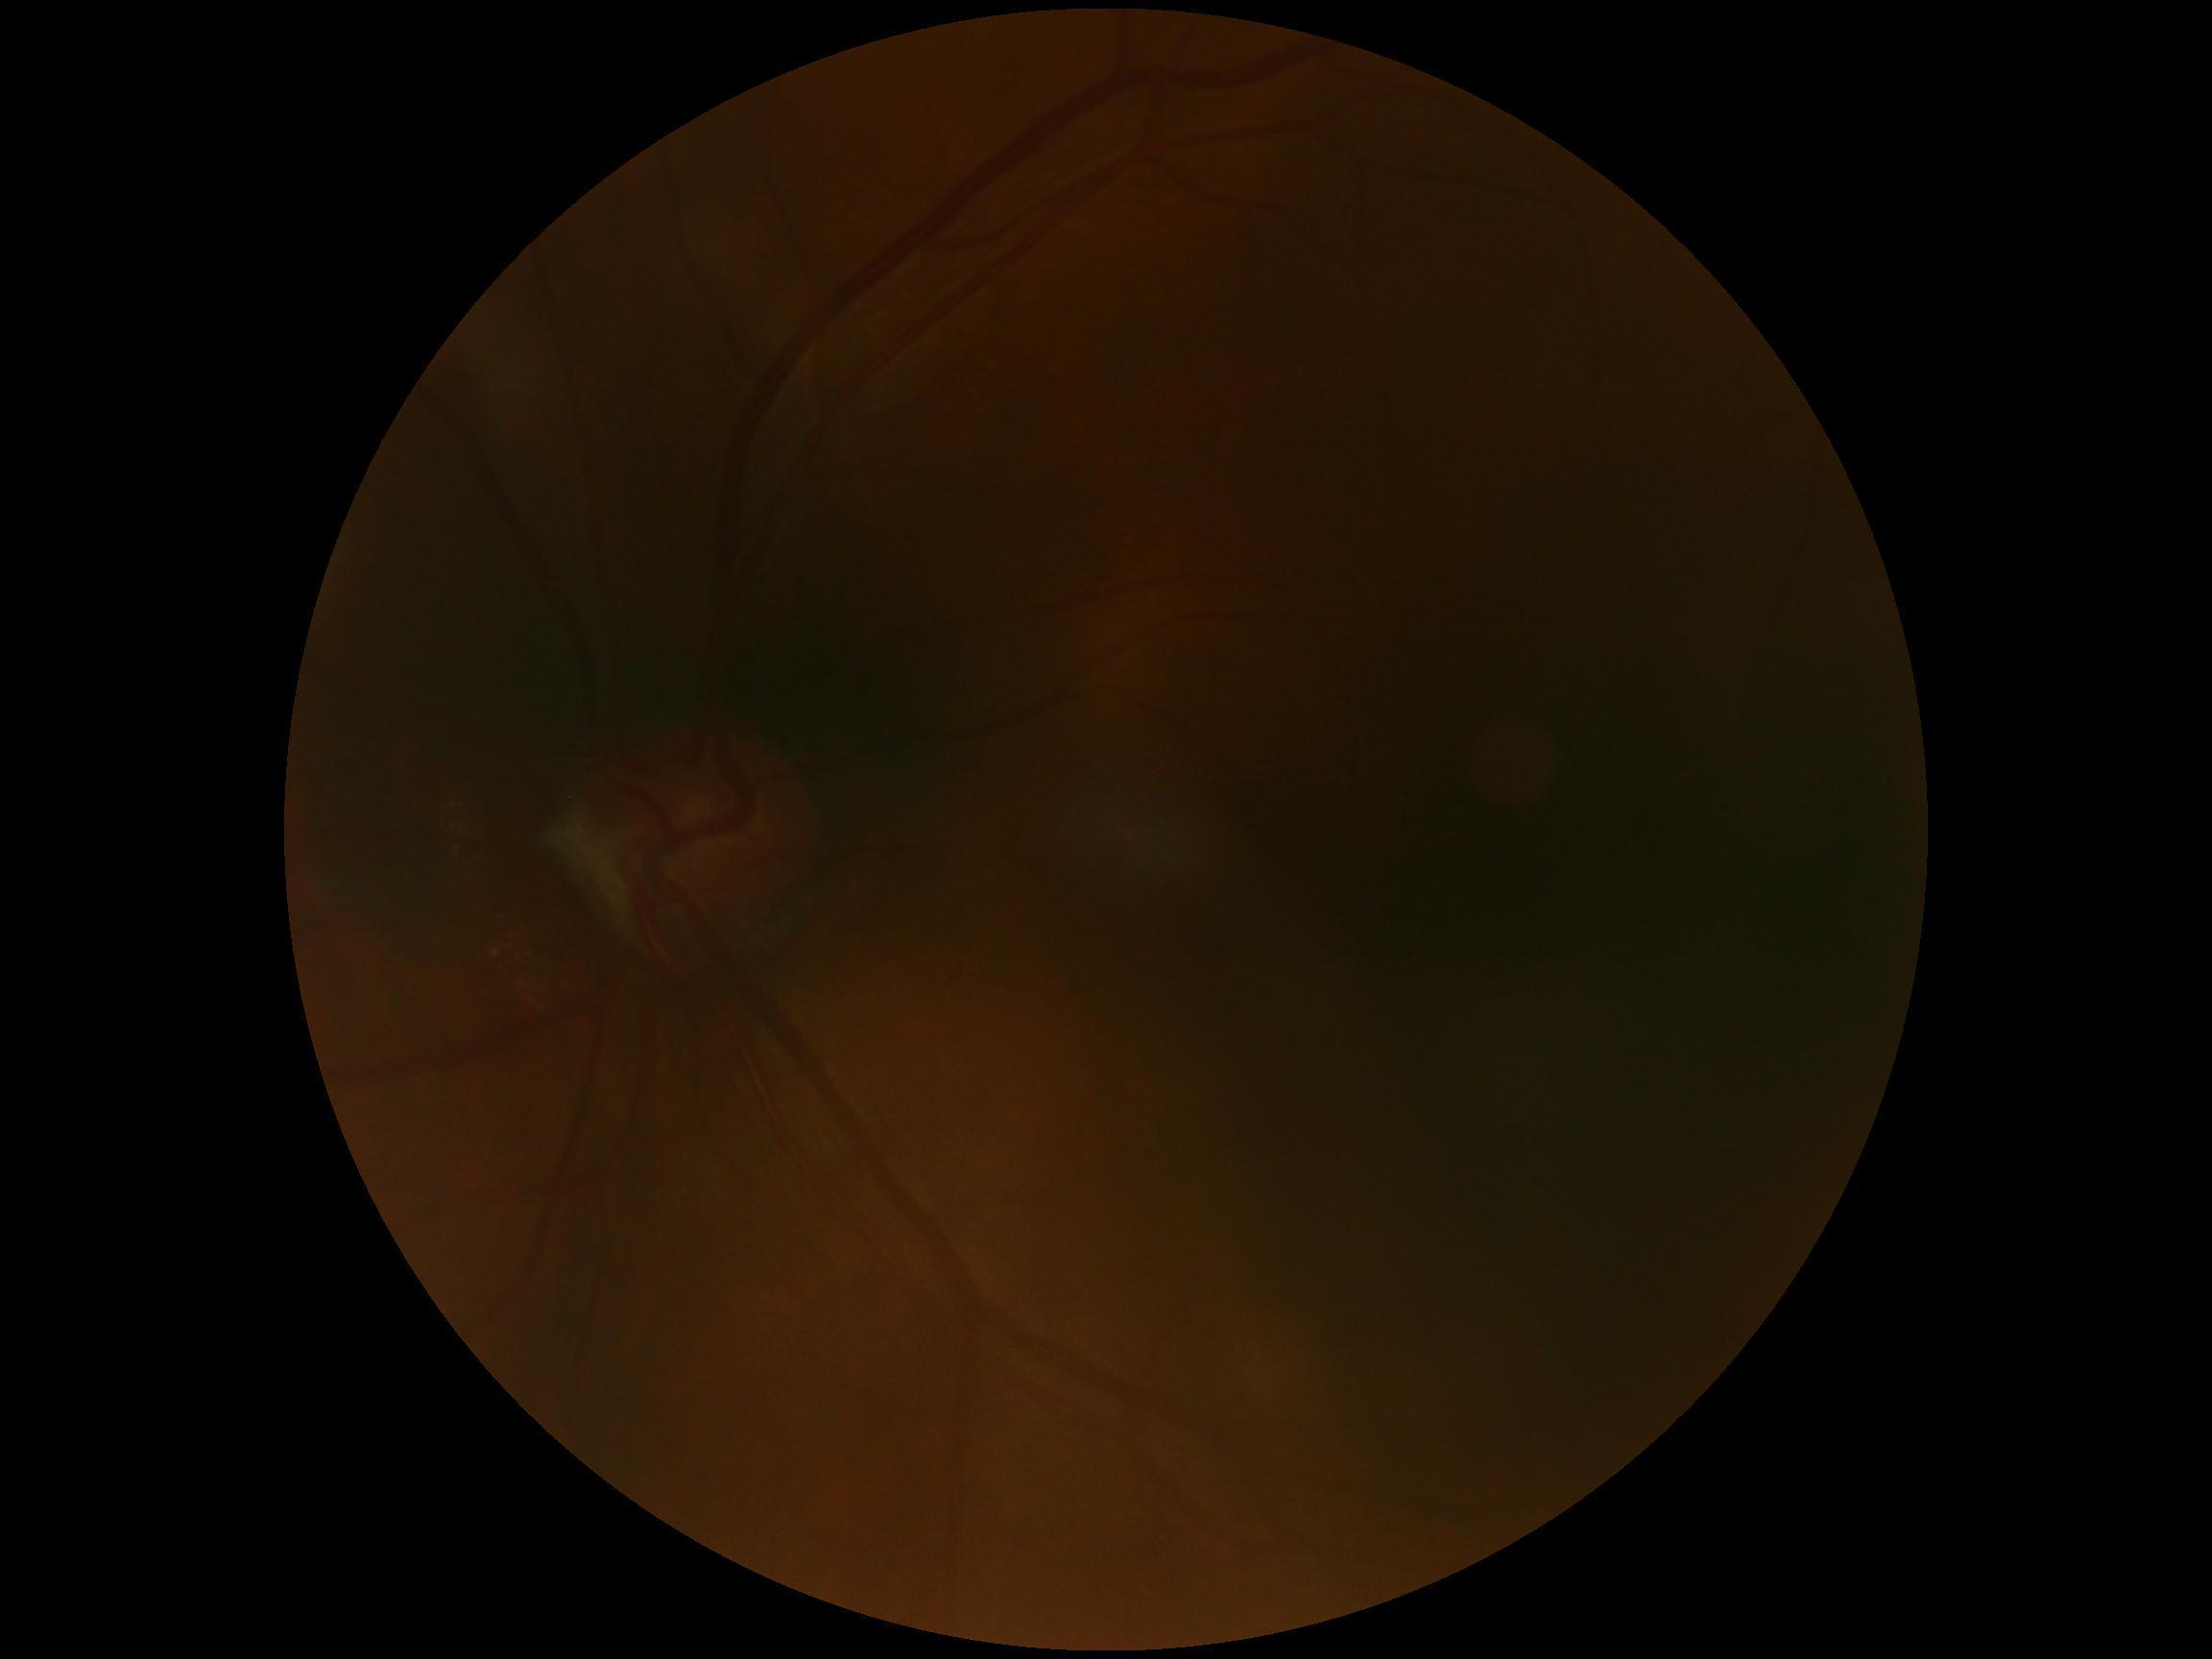
No DR findings. DR stage is 0/4.